Phoenix ICON wide-field infant fundus image.
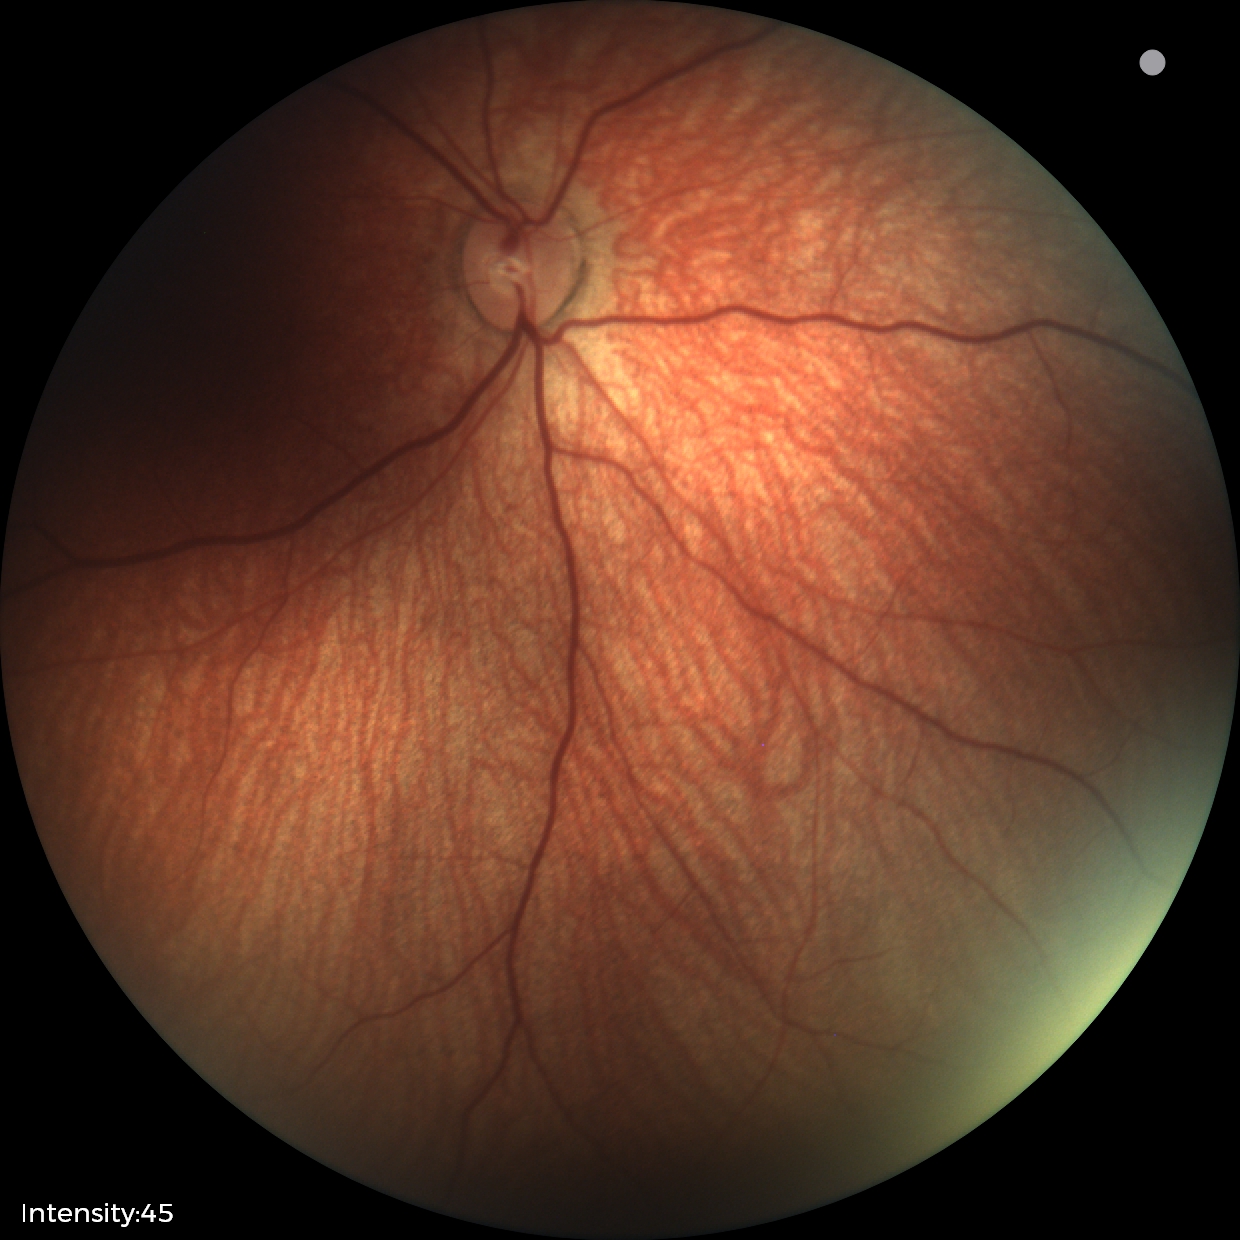
Screening examination with no abnormal retinal findings.